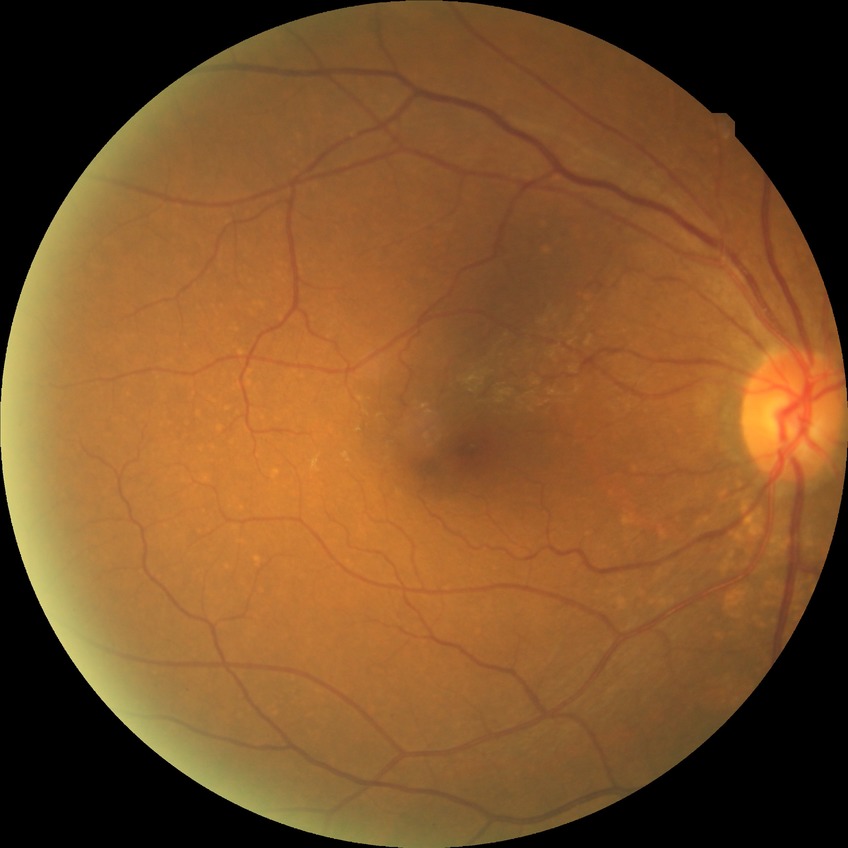

Findings:
• diabetic retinopathy (DR): NDR (no diabetic retinopathy)